Retinal fundus photograph:
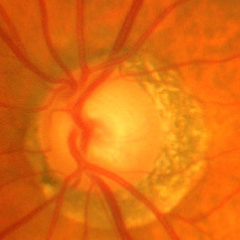 Advanced glaucoma.